Wide-field fundus photograph of an infant
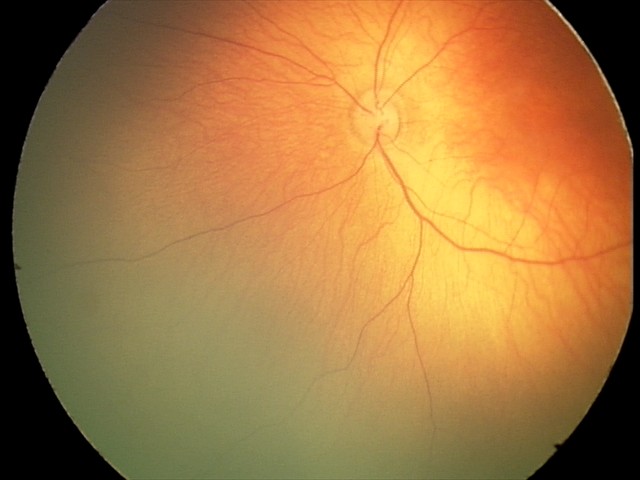 Screening examination consistent with retinal hemorrhages.